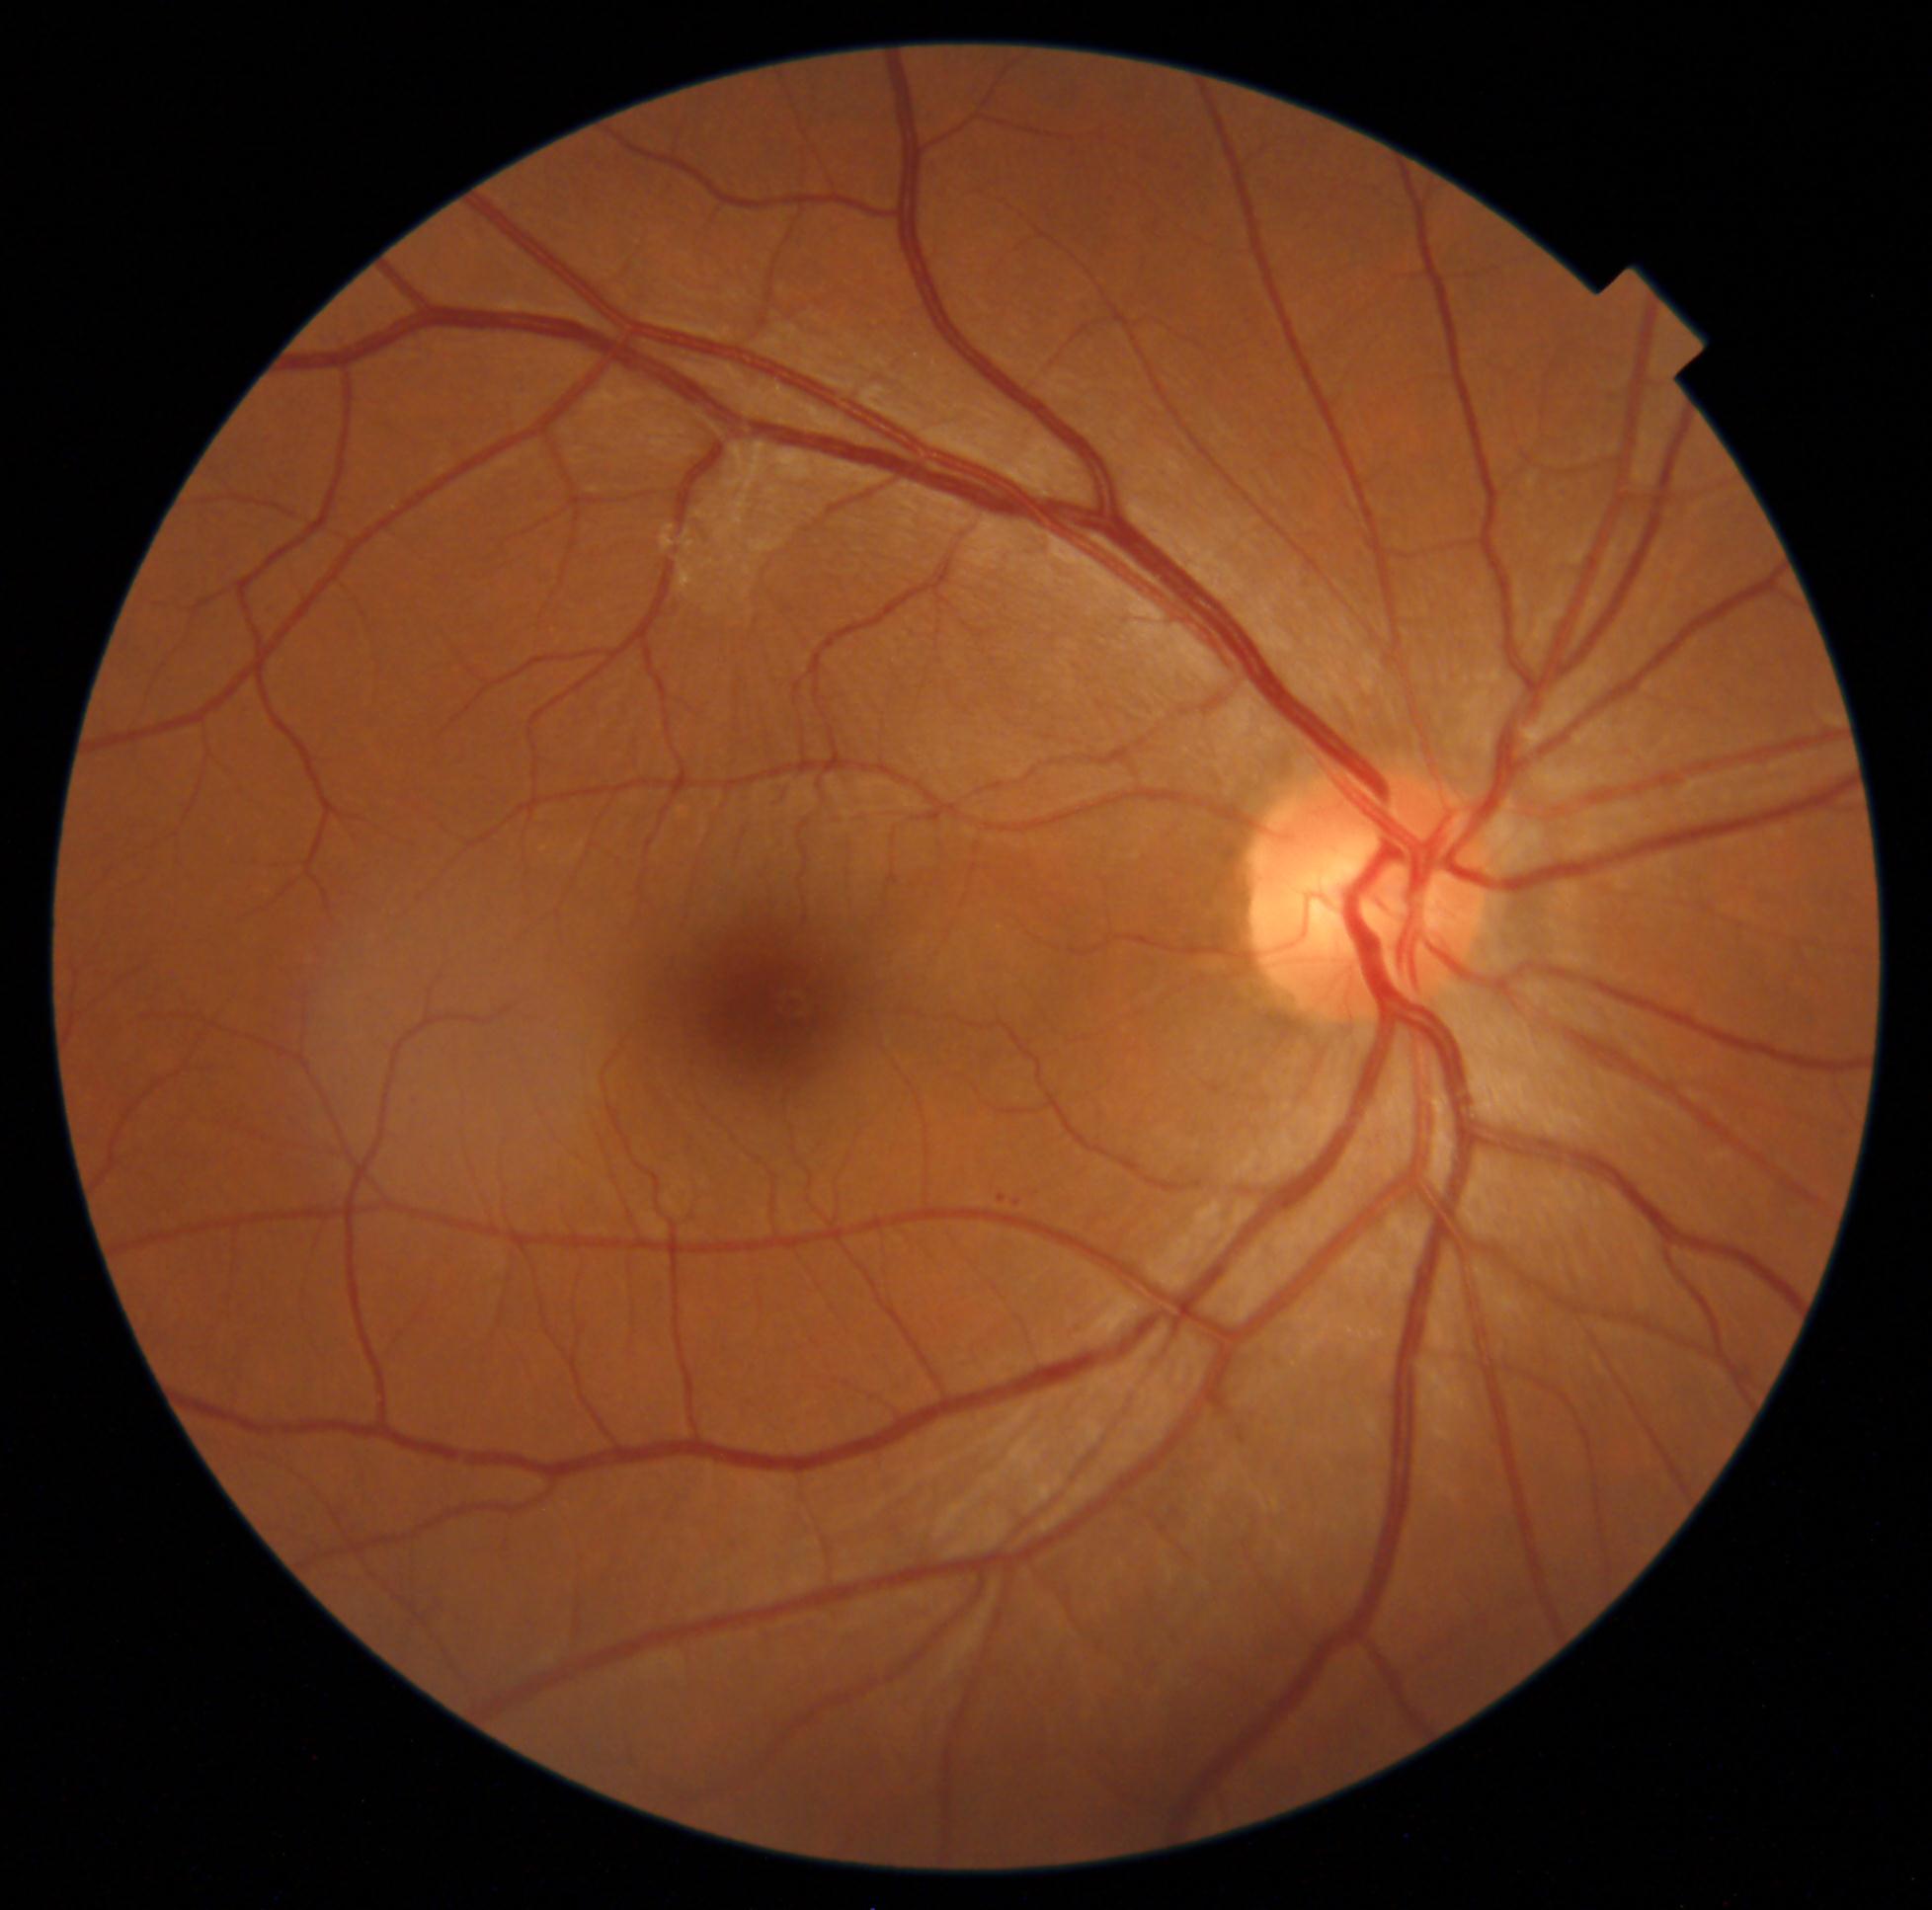

Diabetic retinopathy grade is 1
microaneurysms: [left=1014, top=1200, right=1021, bottom=1208], [left=999, top=1195, right=1007, bottom=1204]
hard exudates: none detected
hemorrhages: none detected
soft exudates: none detected